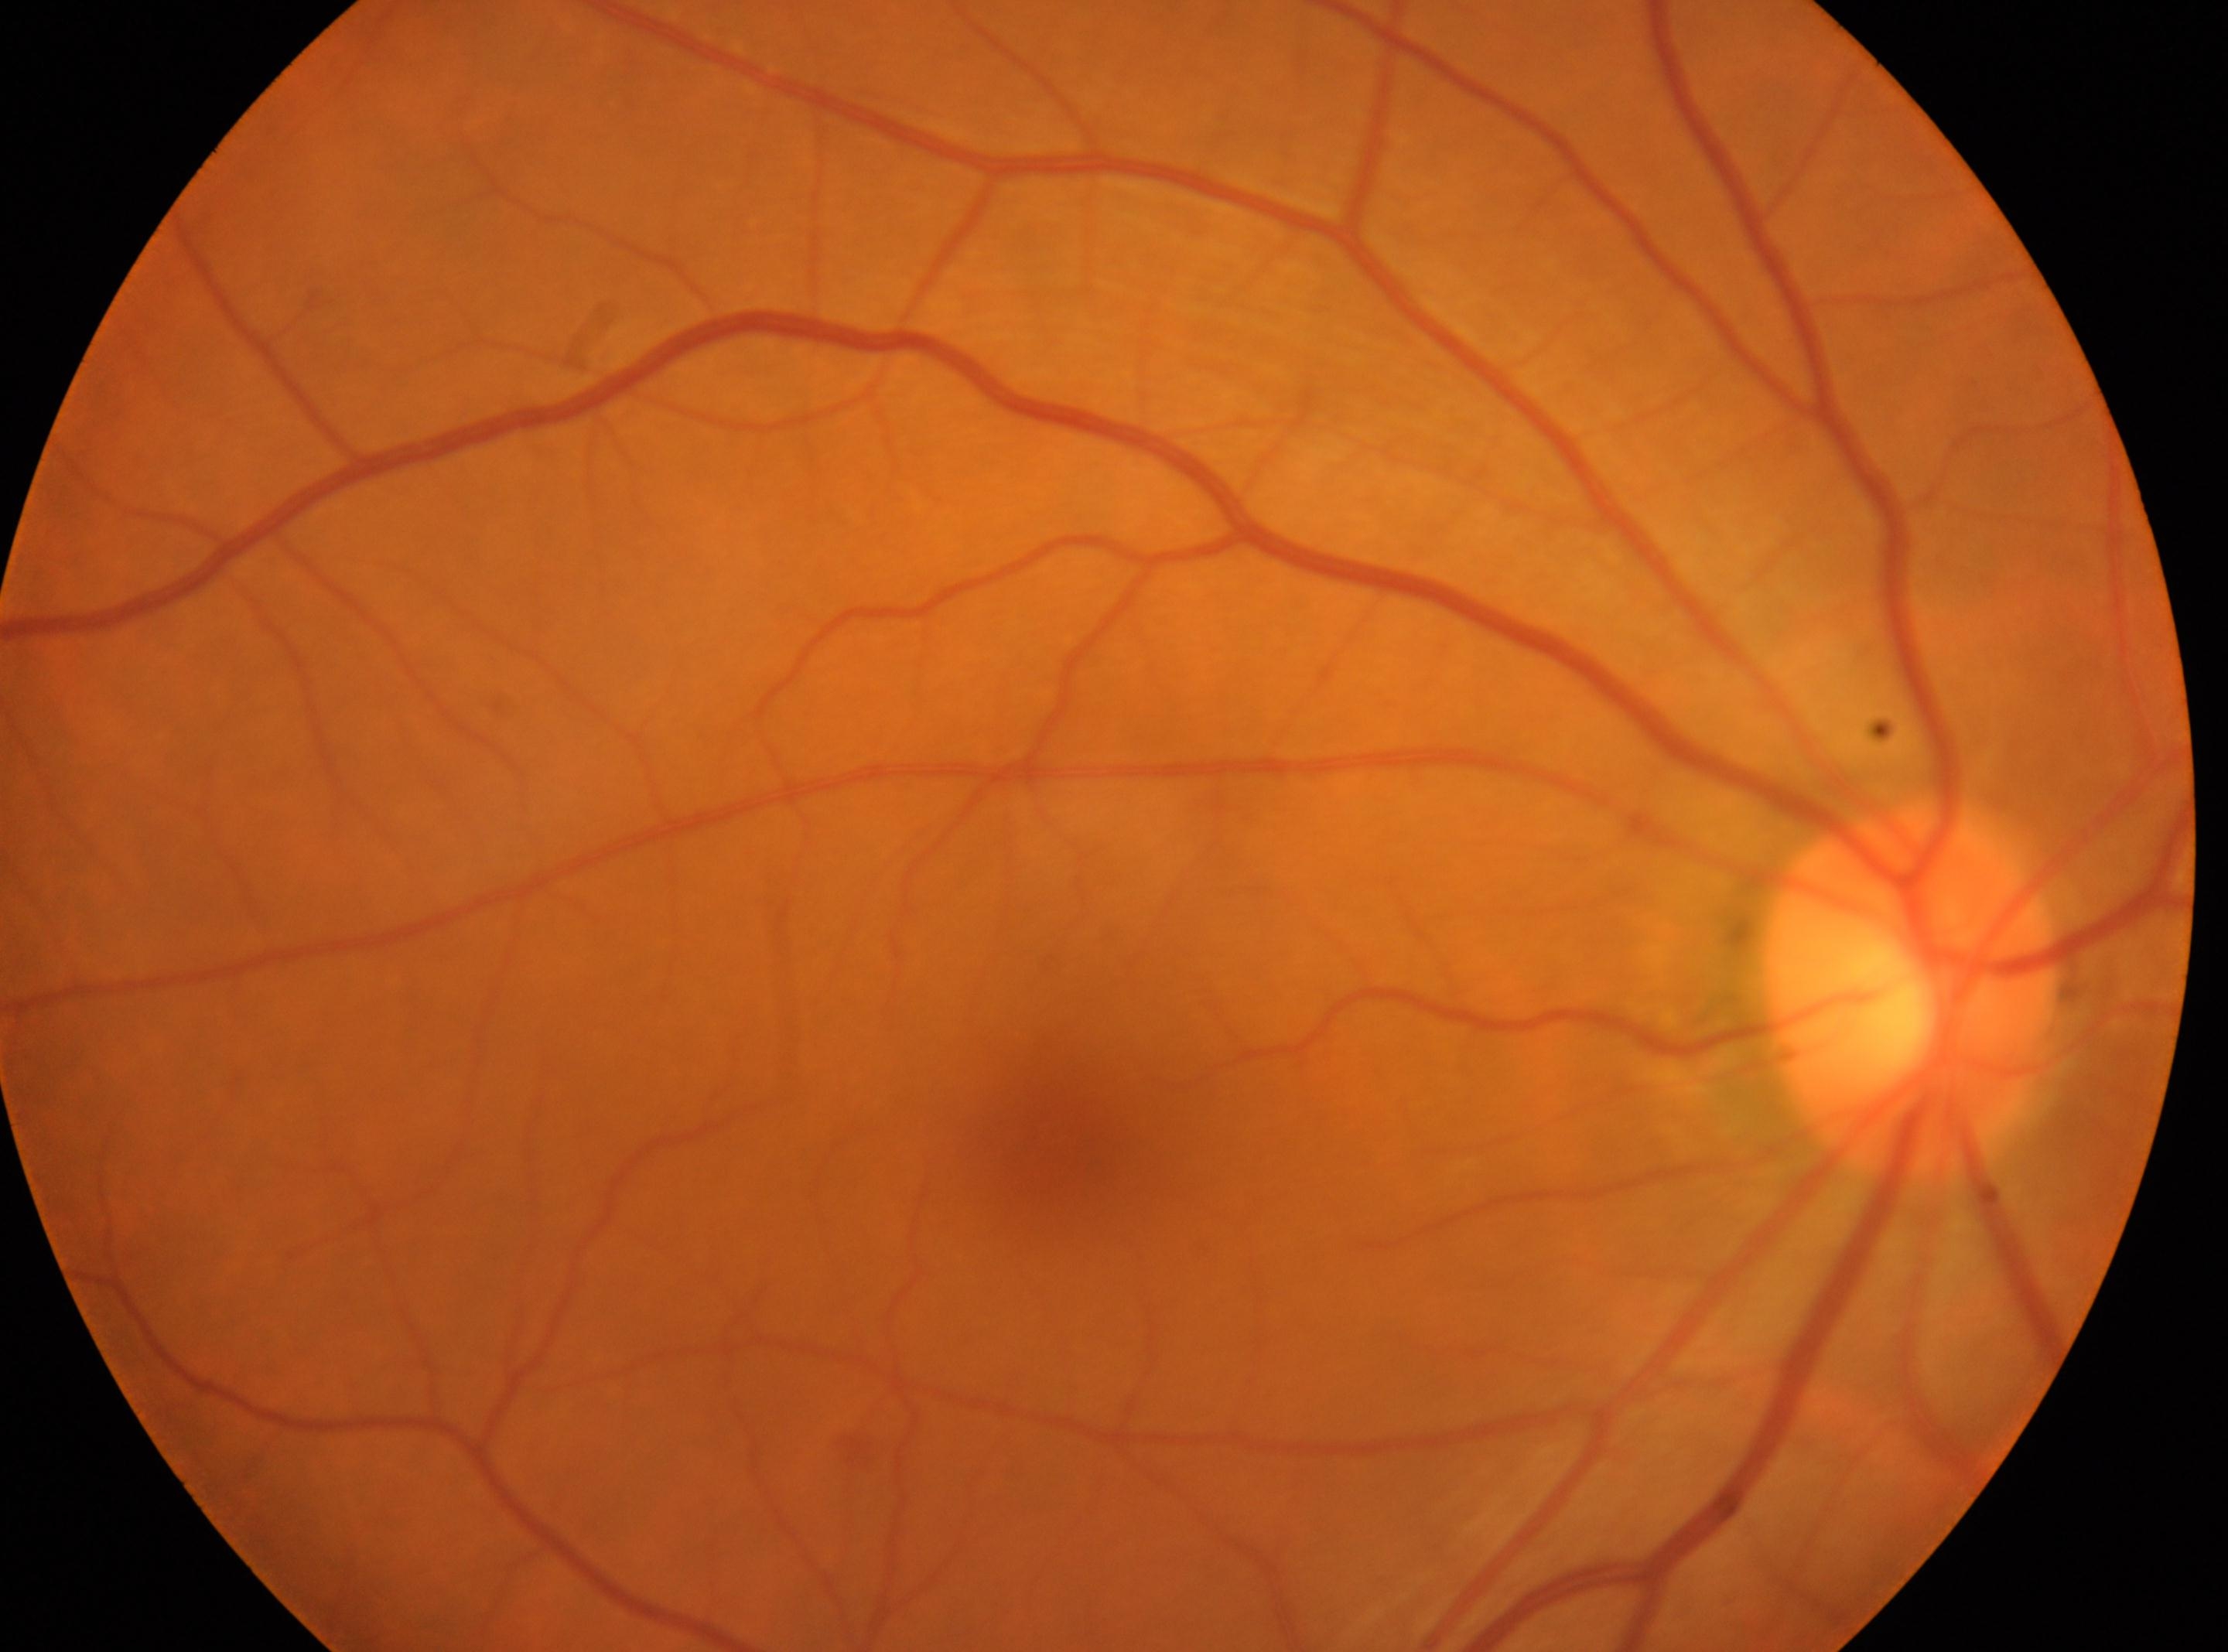 fovea = (x: 1060, y: 1151) | optic disc = (x: 1910, y: 994) | laterality = right | DR impression = No DR findings | DR severity = no apparent diabetic retinopathy (grade 0).